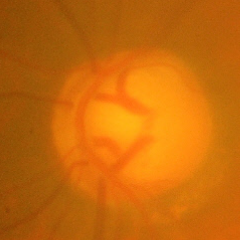 Q: Glaucoma assessment?
A: Advanced glaucoma.